1440 x 1080 pixels — 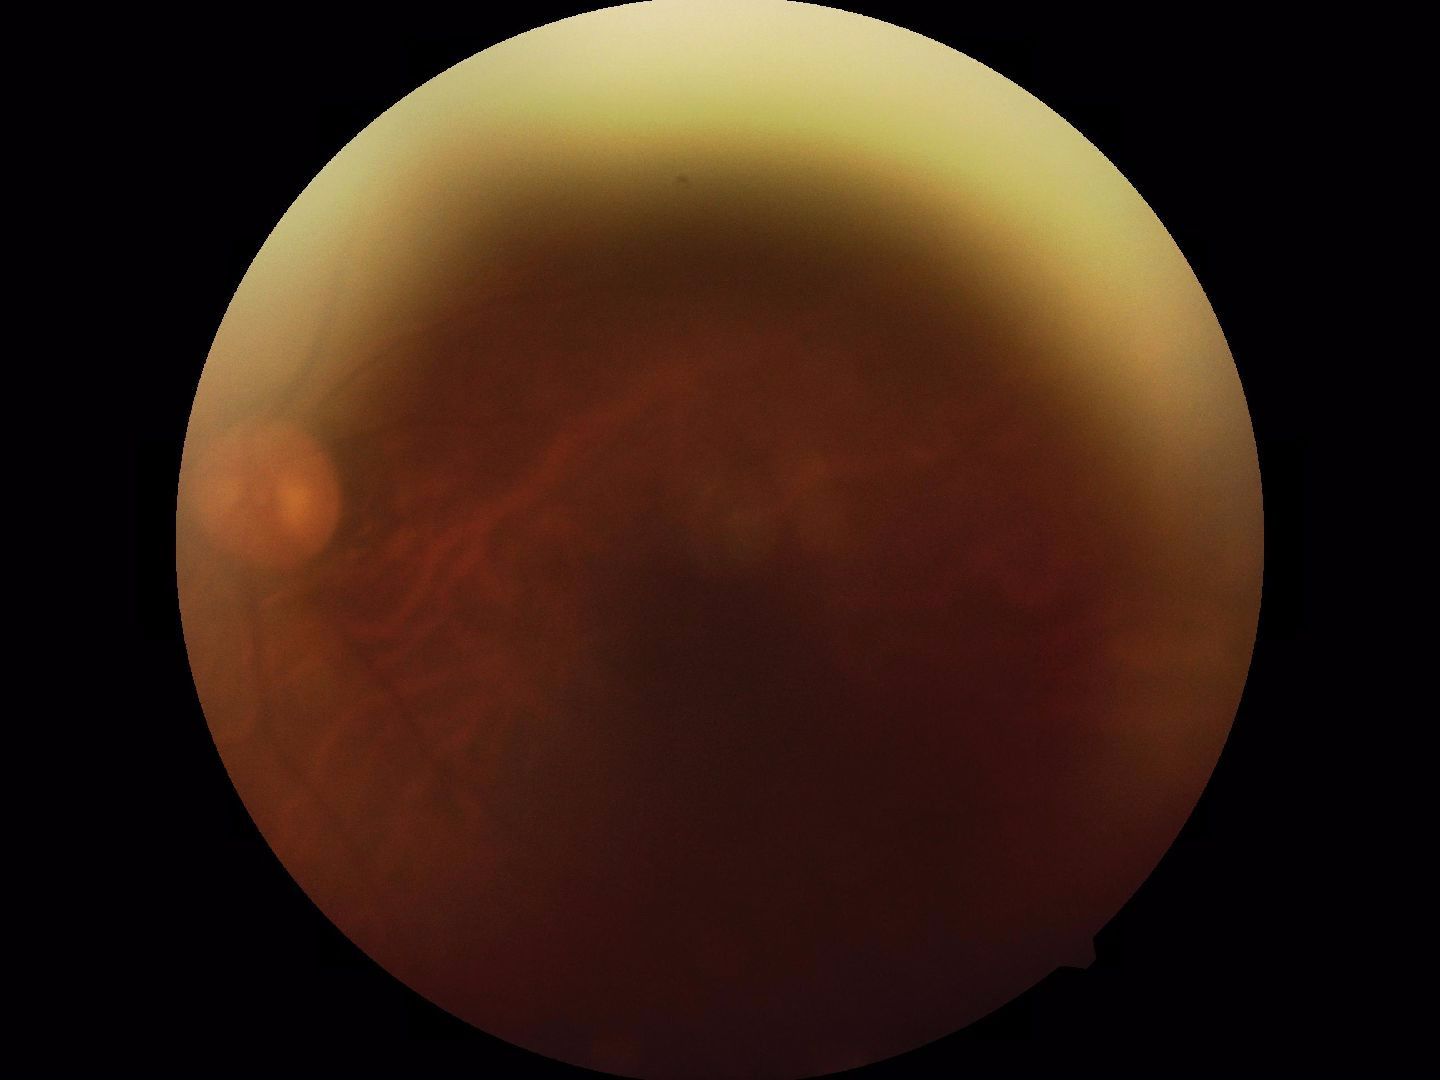
Gradability: blurred, more than half the field obscured. Proliferative retinopathy: not identified.